848 x 848 pixels:
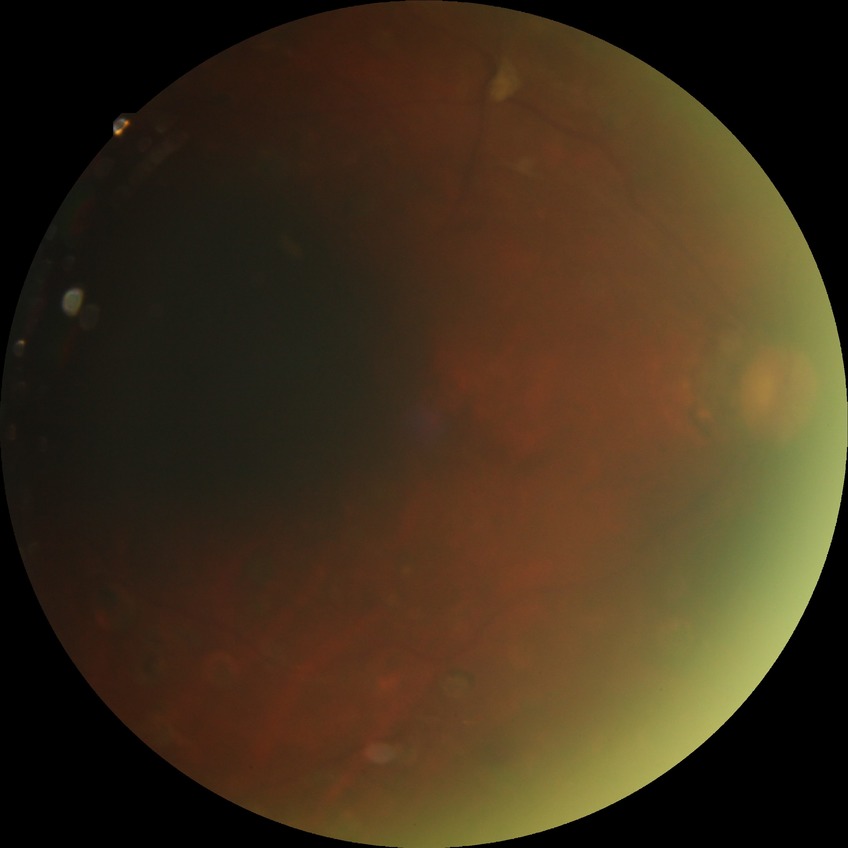

Diabetic retinopathy (DR): PDR (proliferative diabetic retinopathy).